2352 x 1568 pixels — 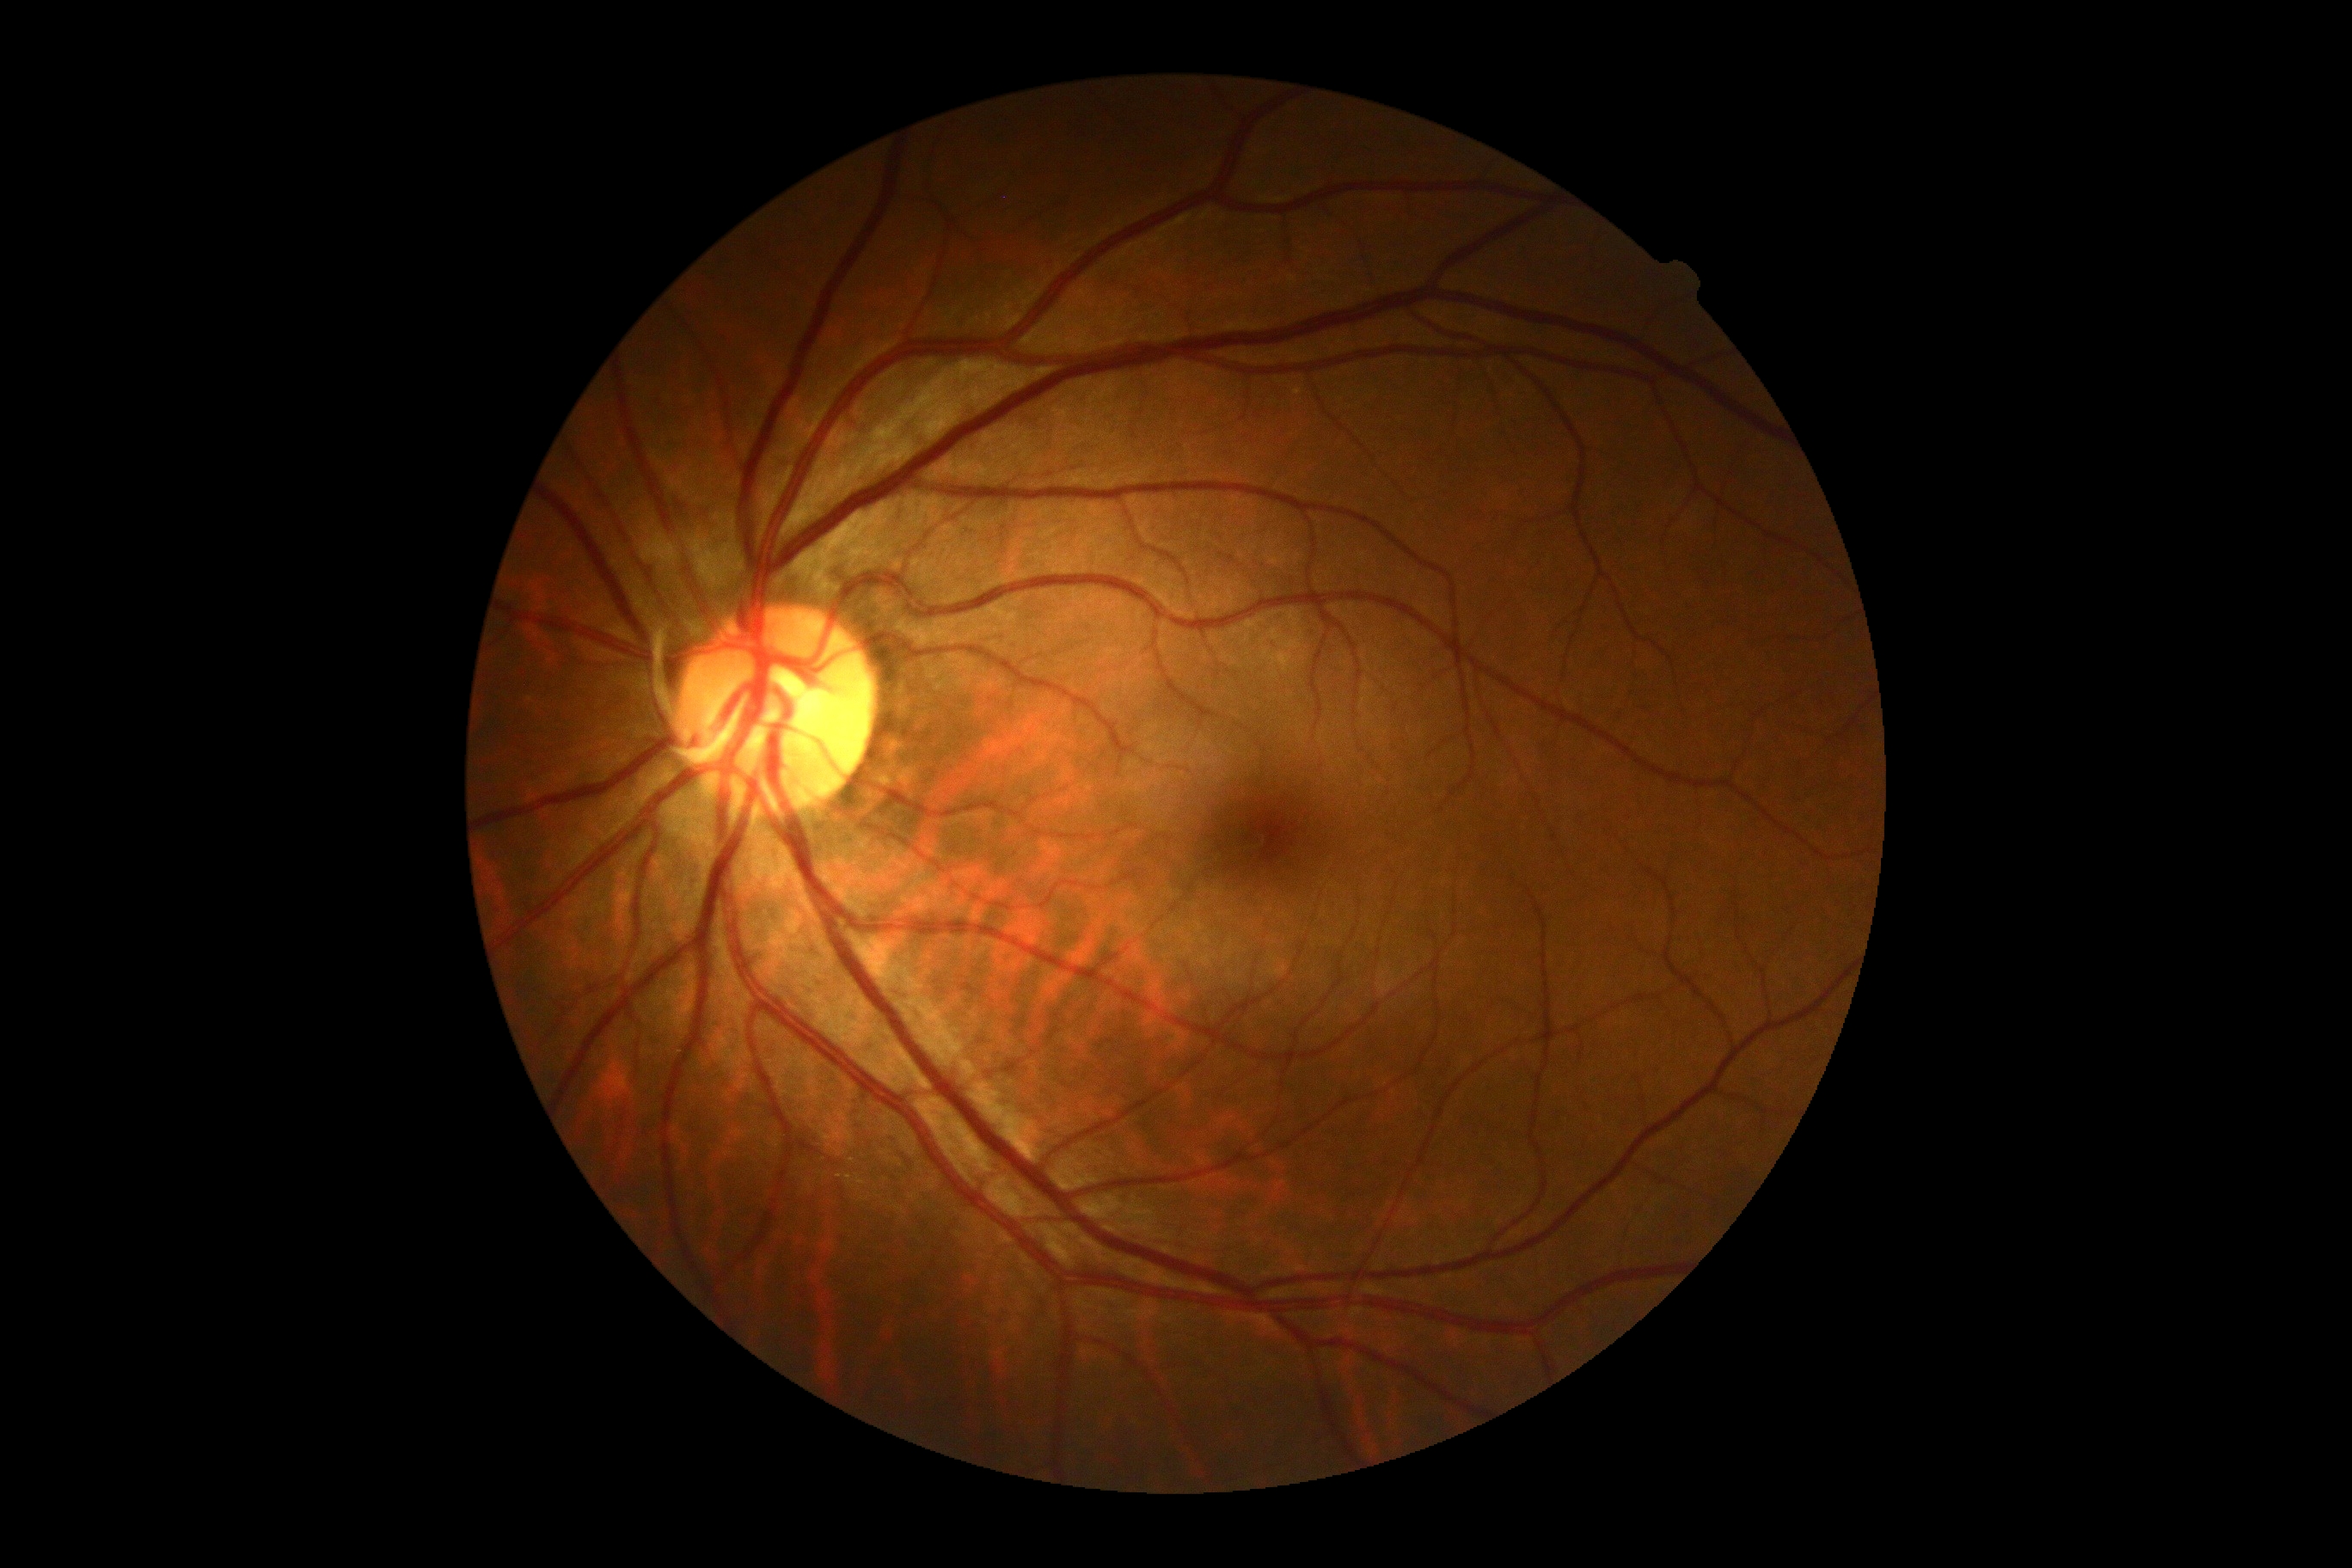

Diabetic retinopathy grade: no apparent diabetic retinopathy (0).
No diabetic retinal disease findings.